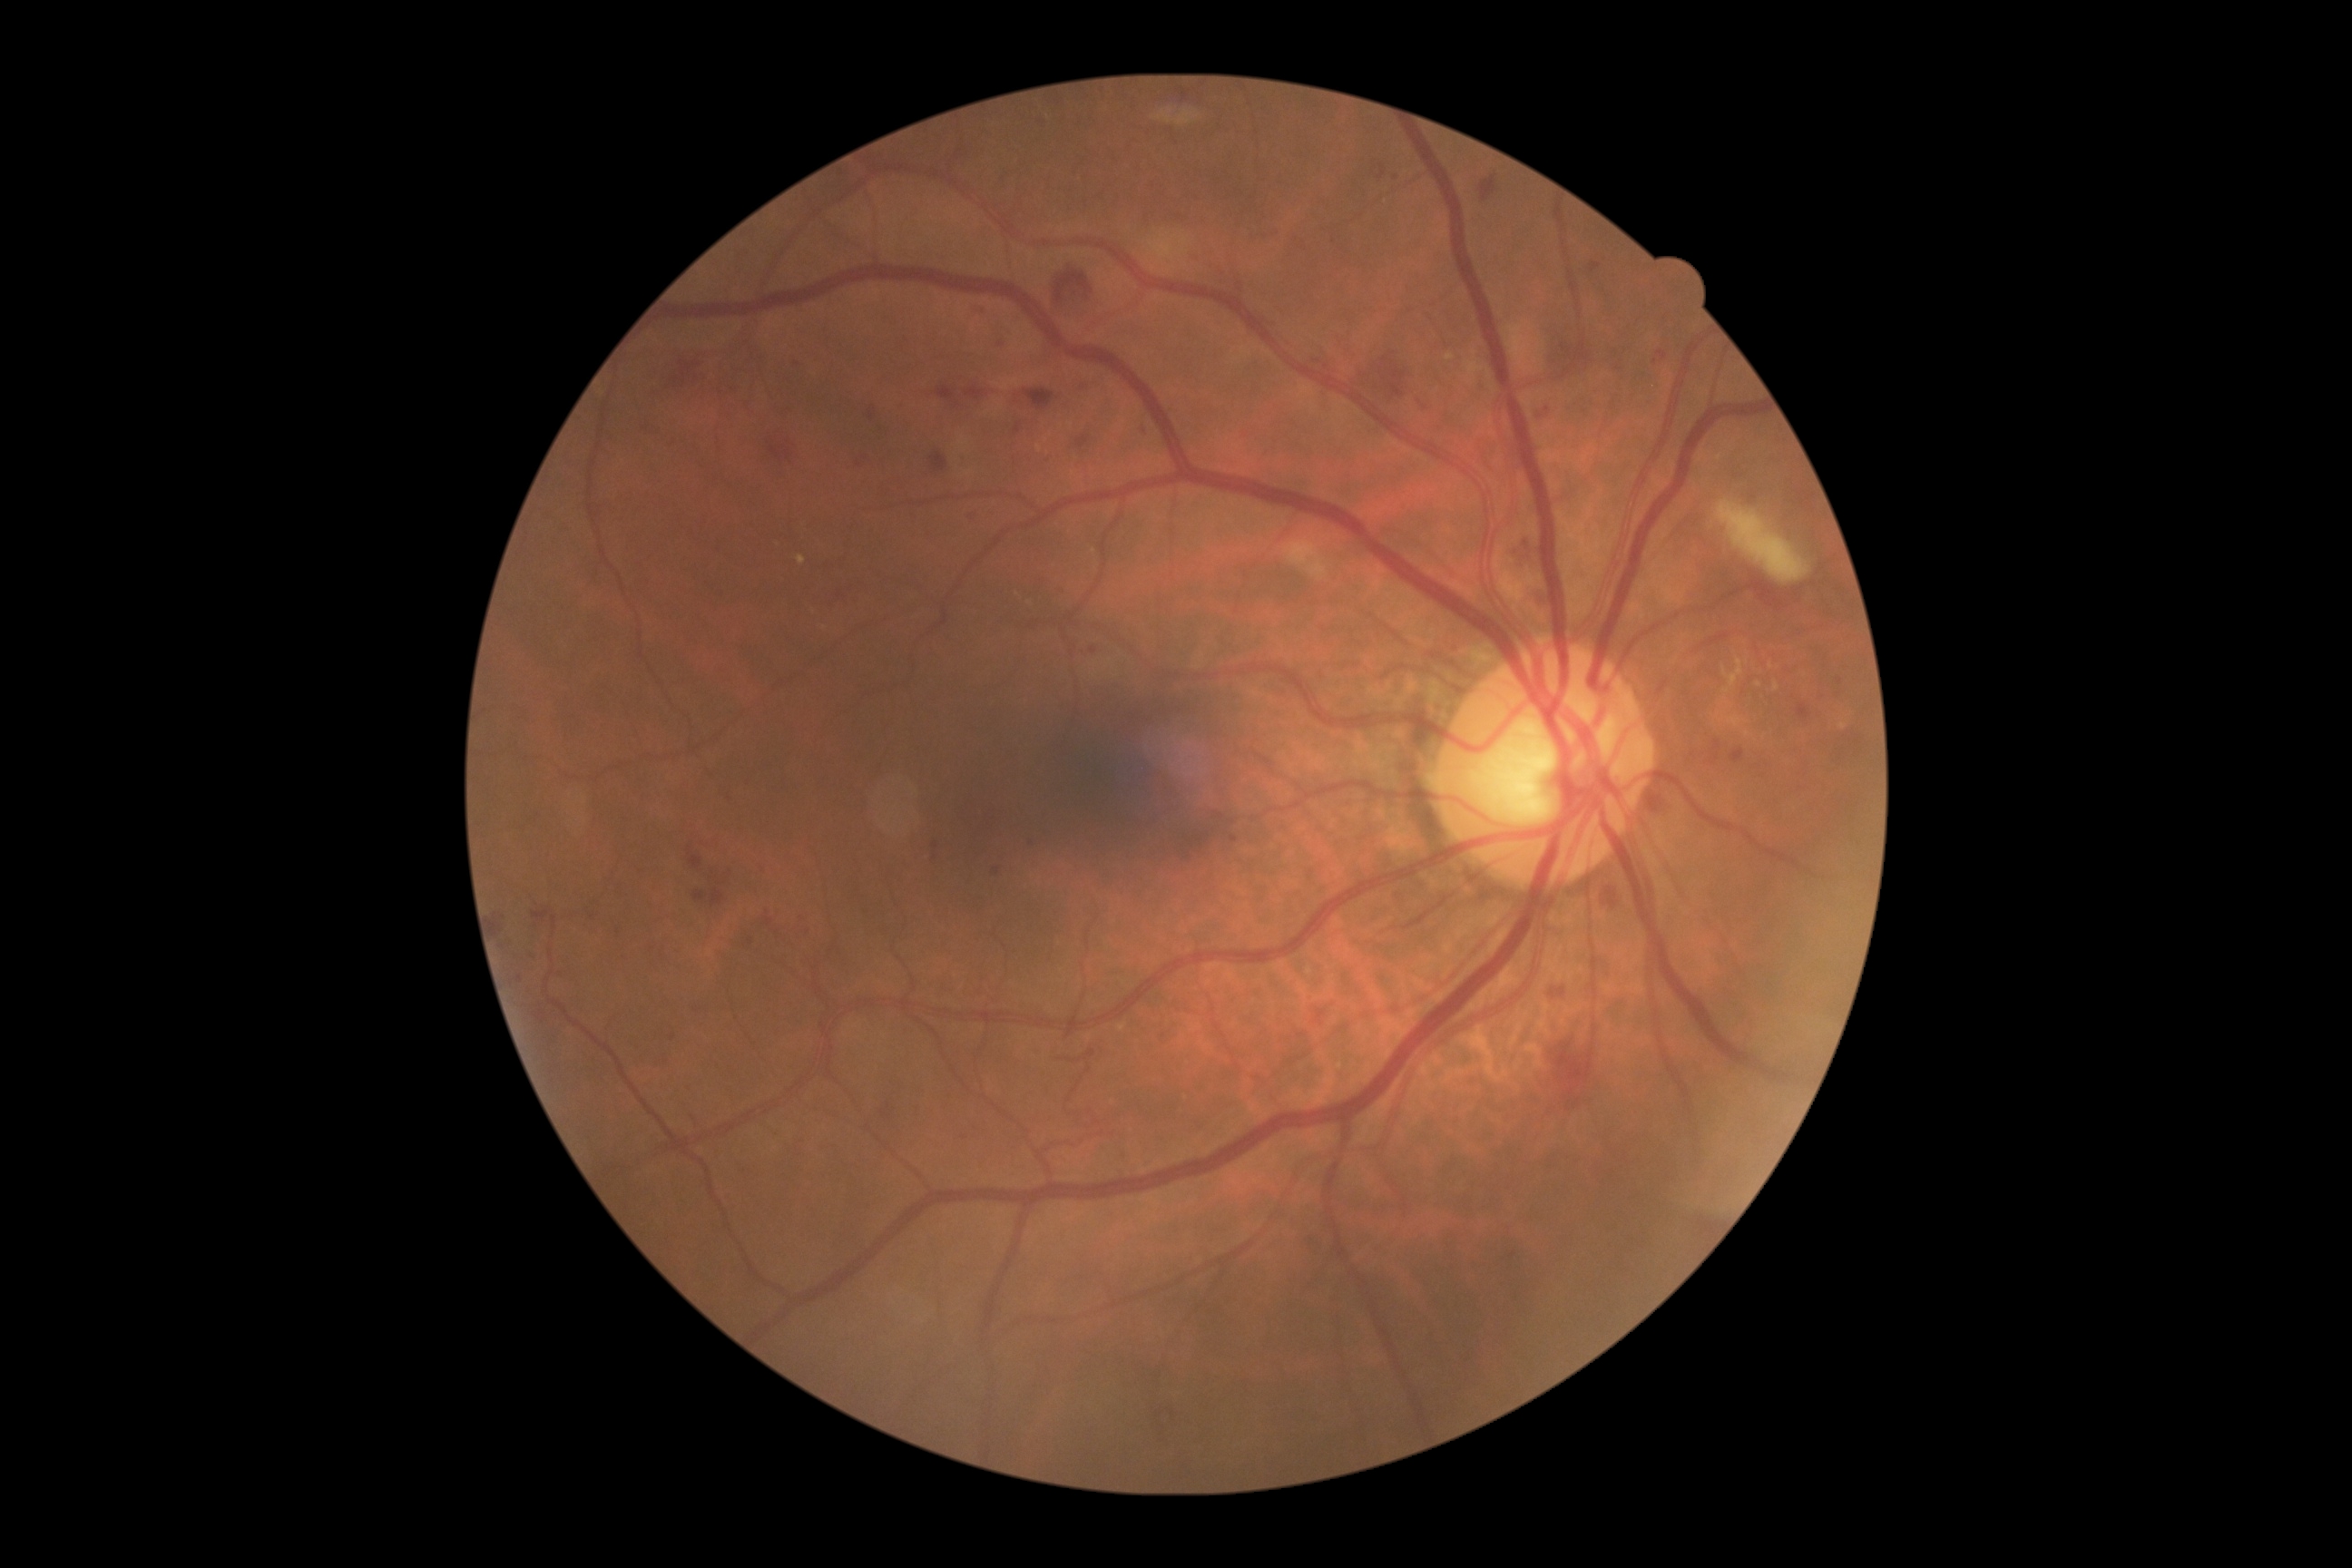

DR: 2.